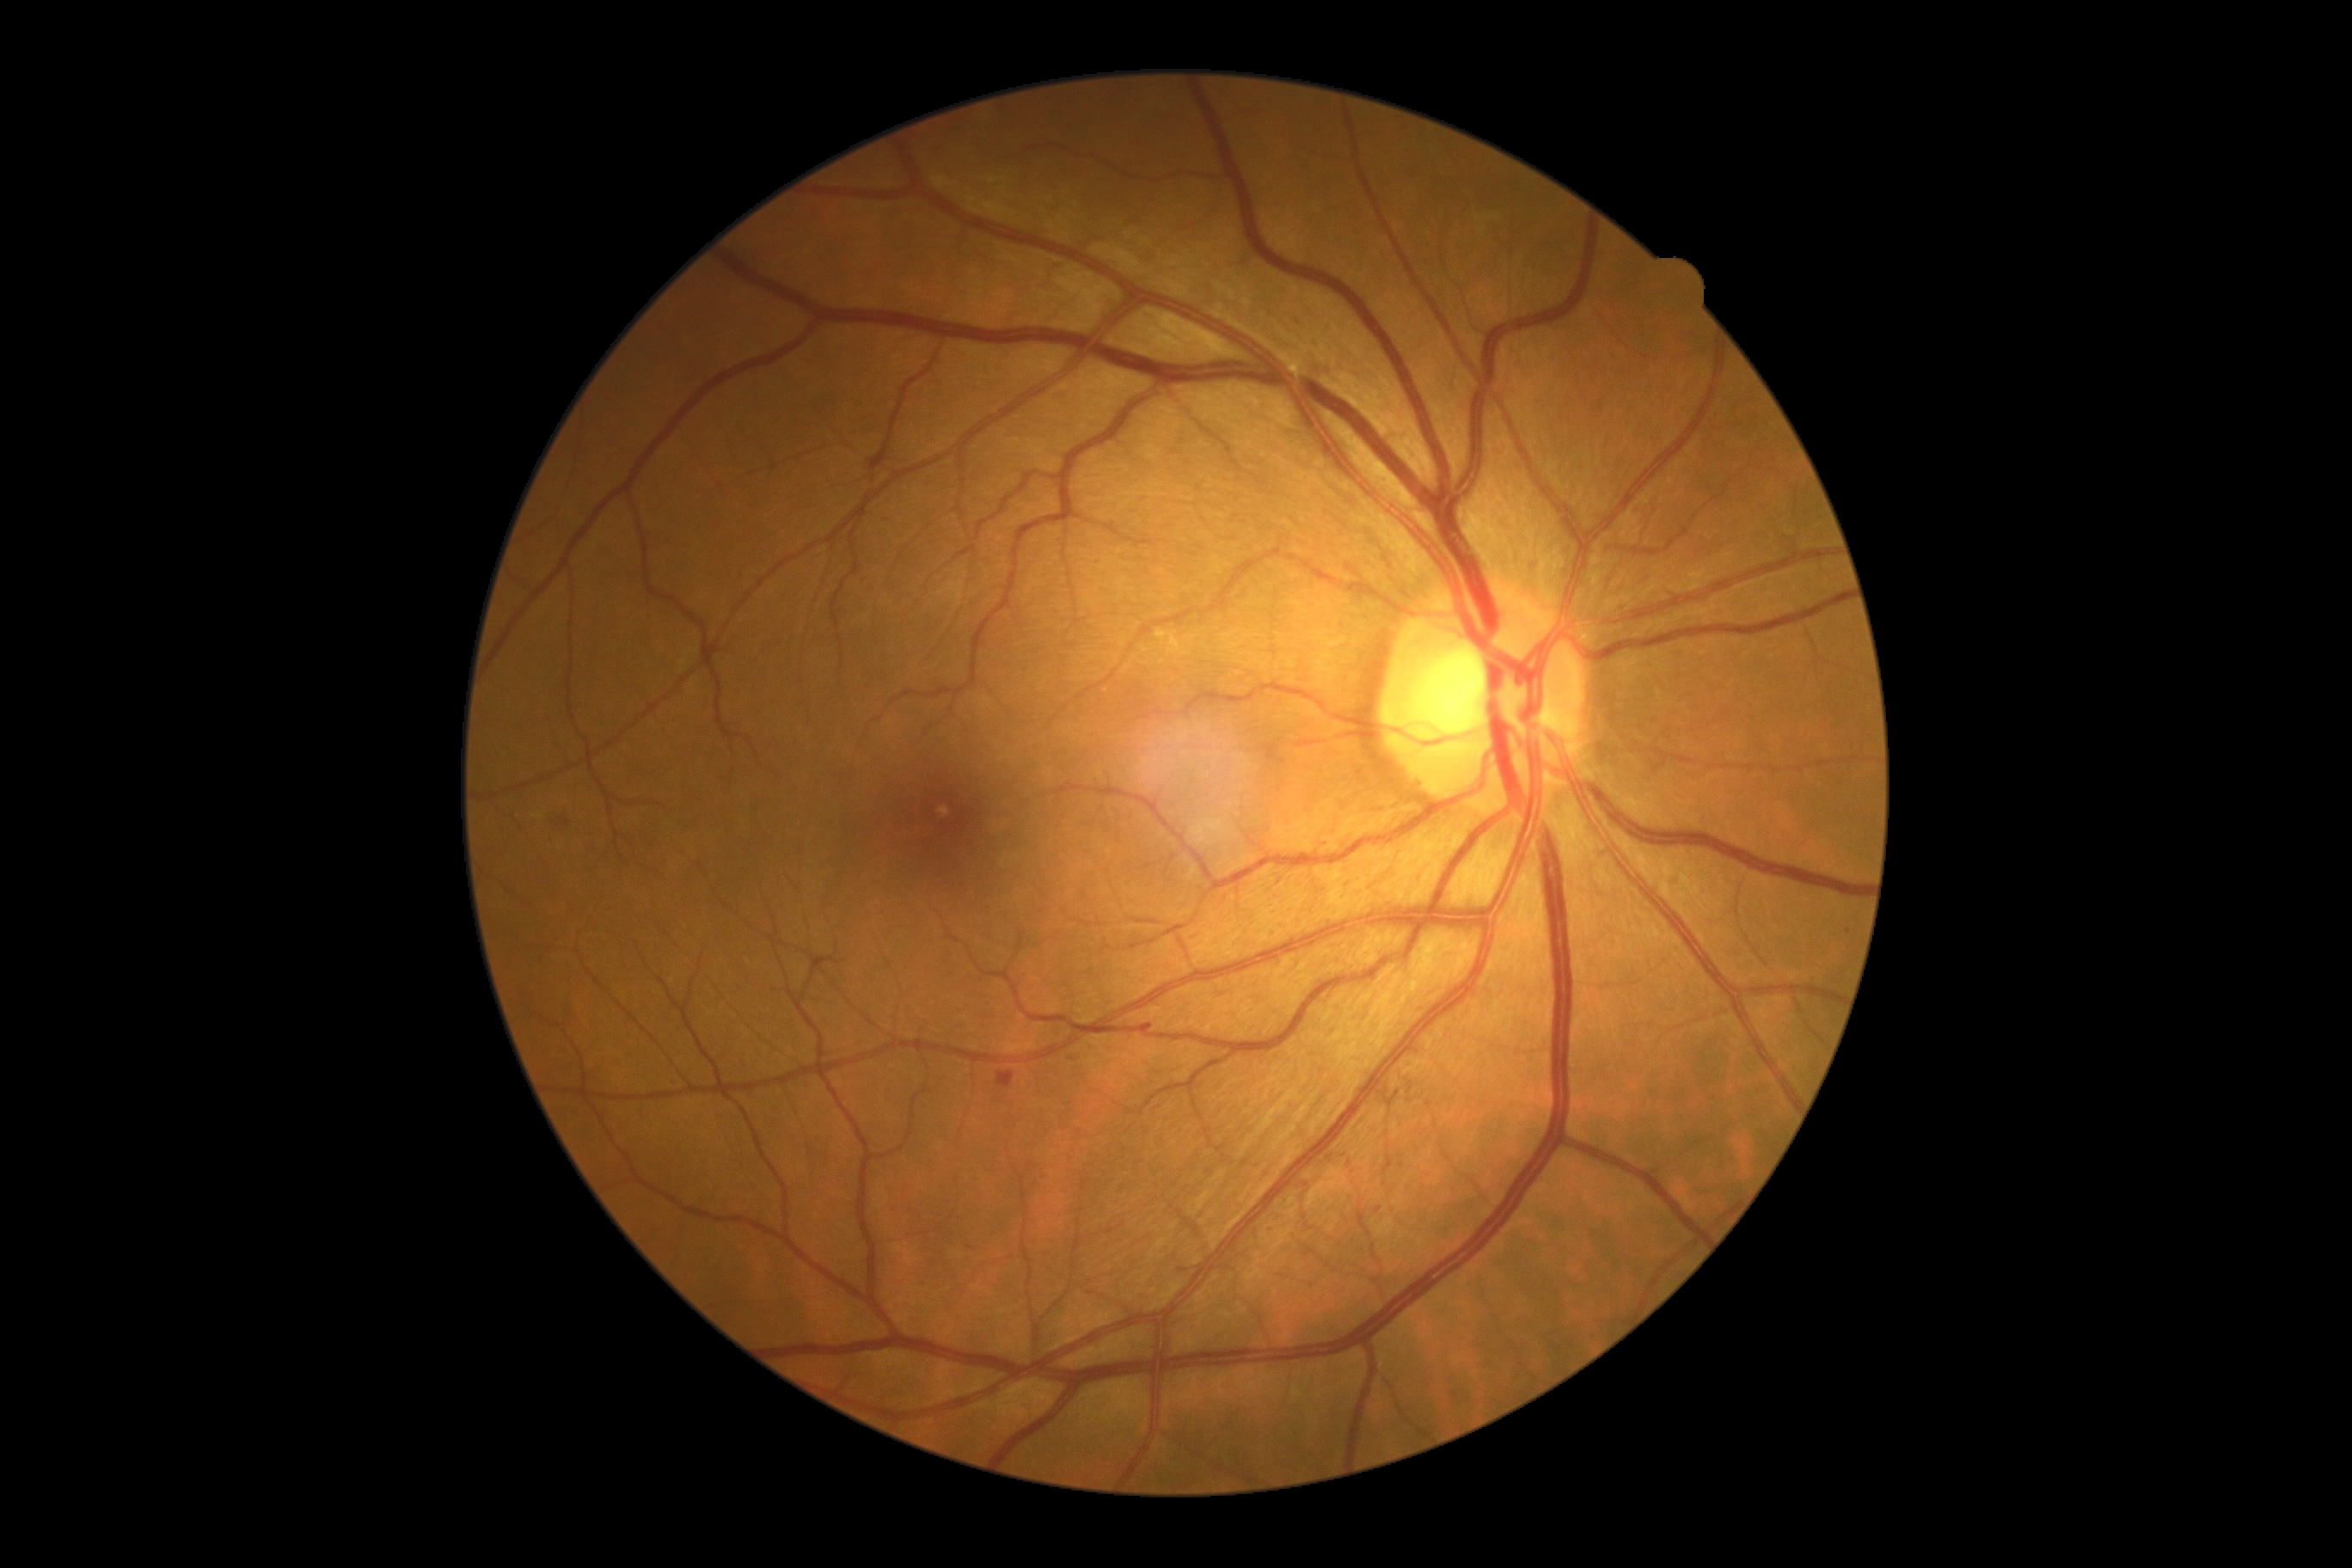   dr_grade: grade 2